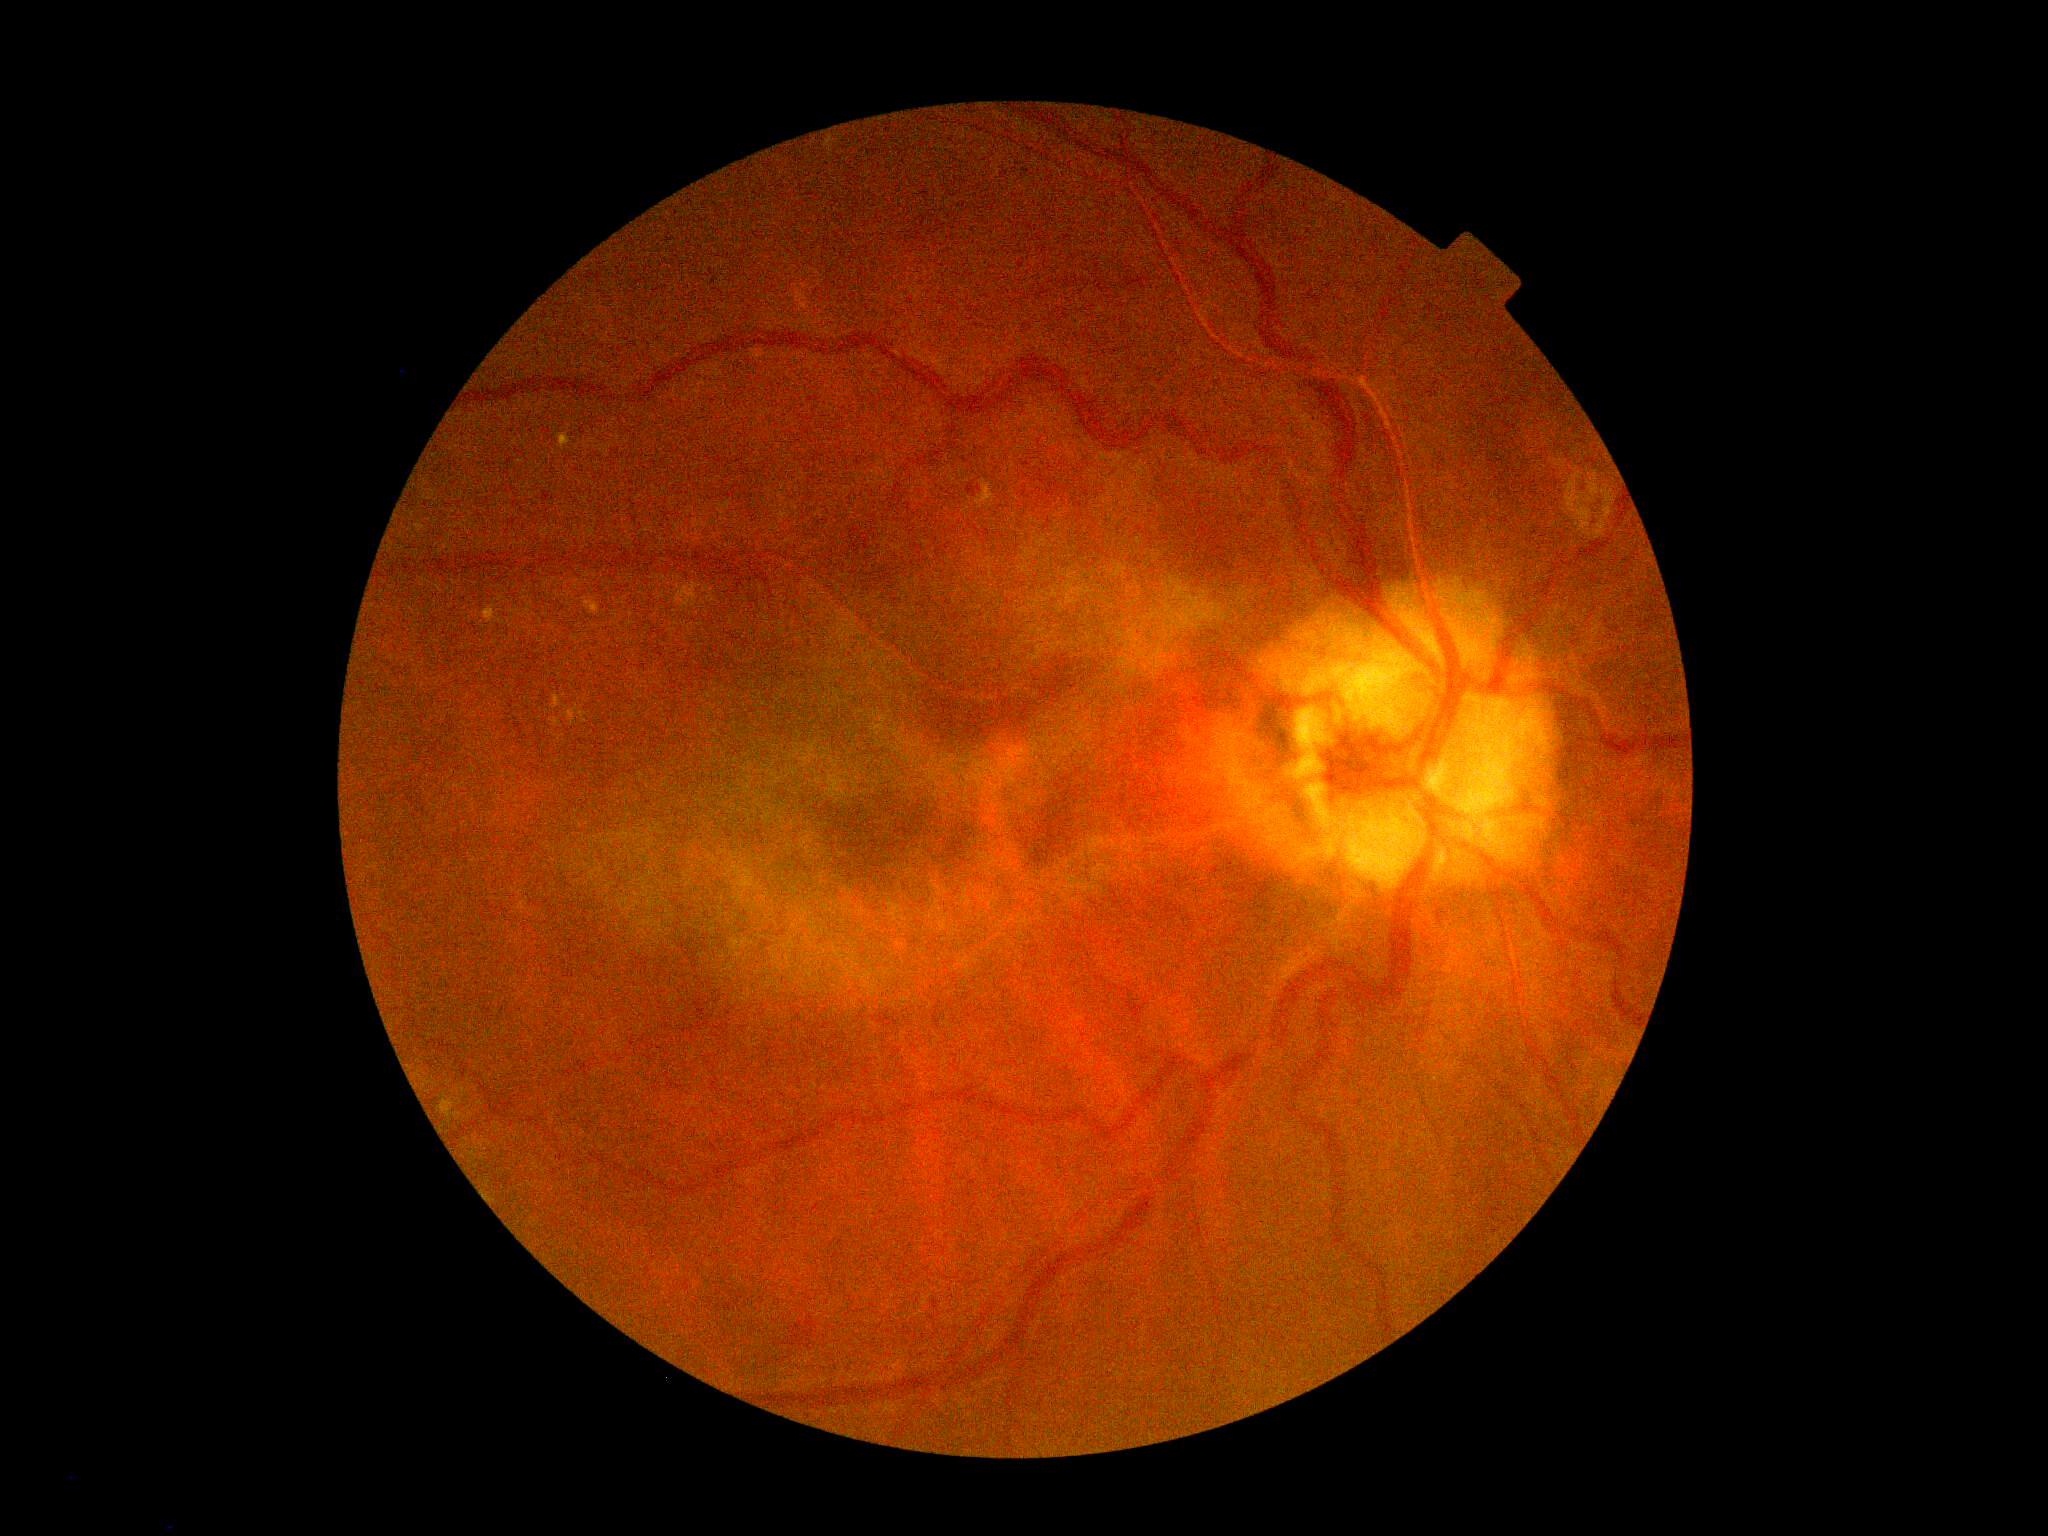 Diabetic retinopathy grade: 2/4.